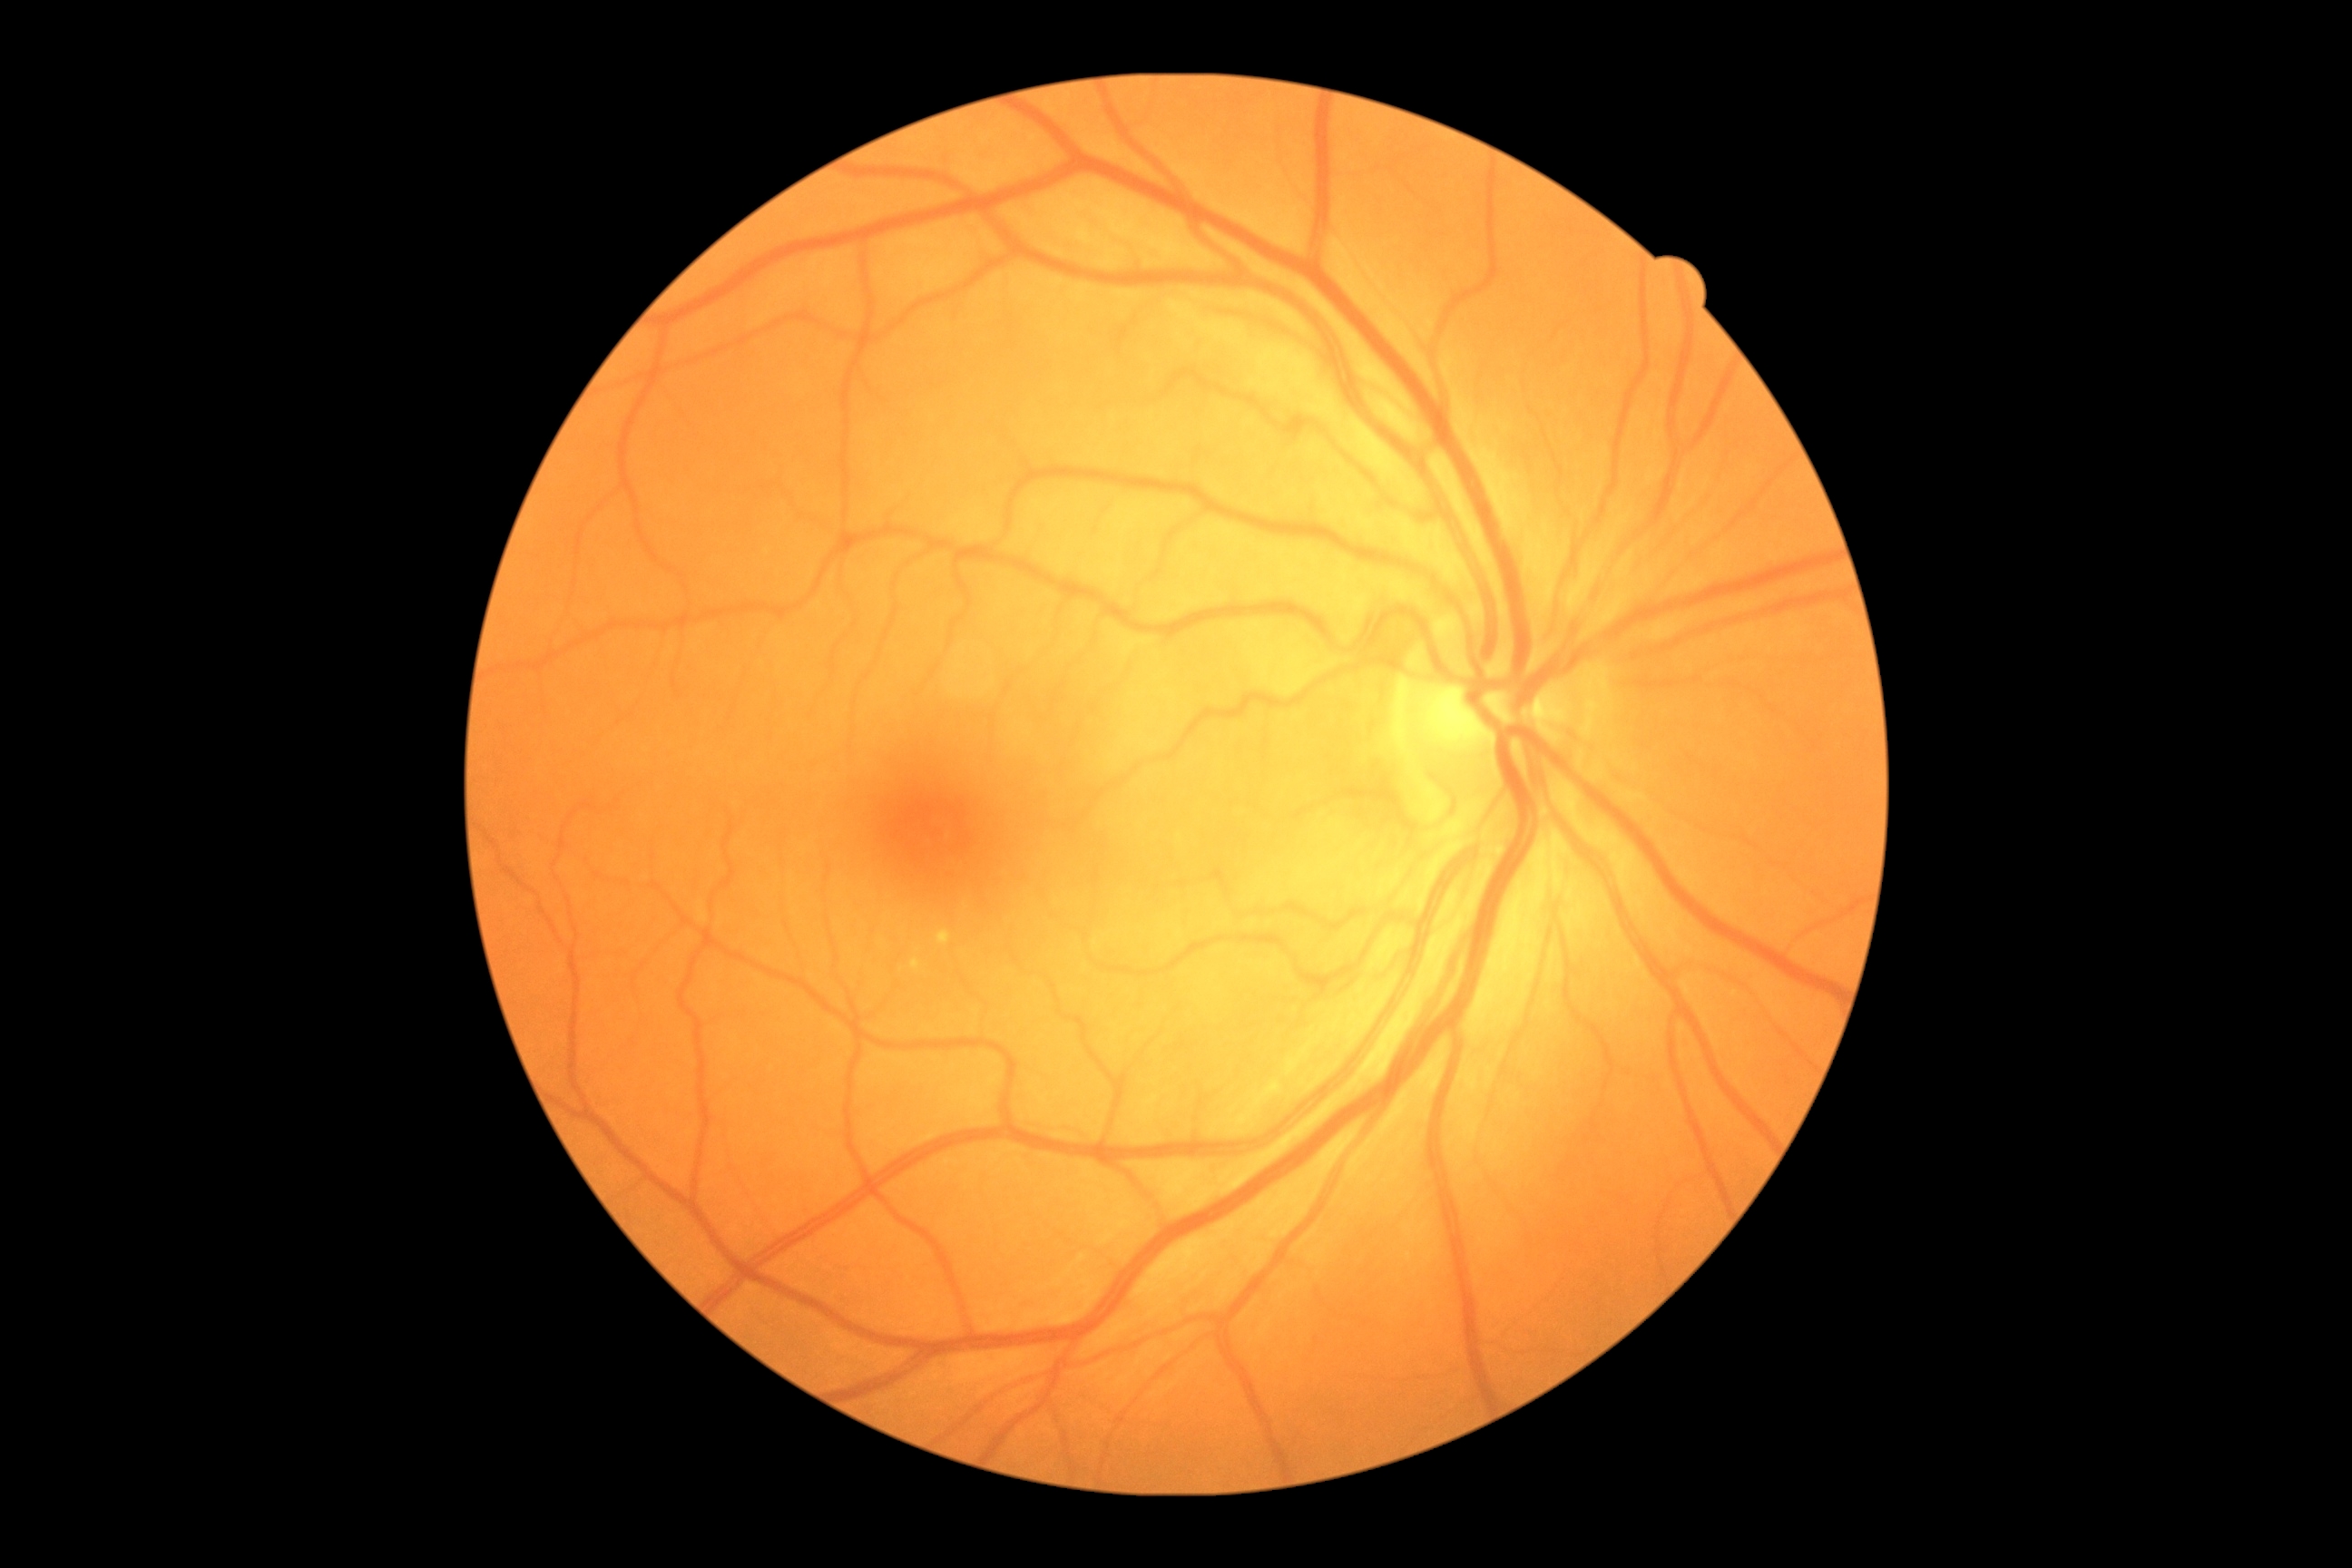
DR severity@grade 0 (no apparent retinopathy) — no visible signs of diabetic retinopathy; DR impression@no DR findings.